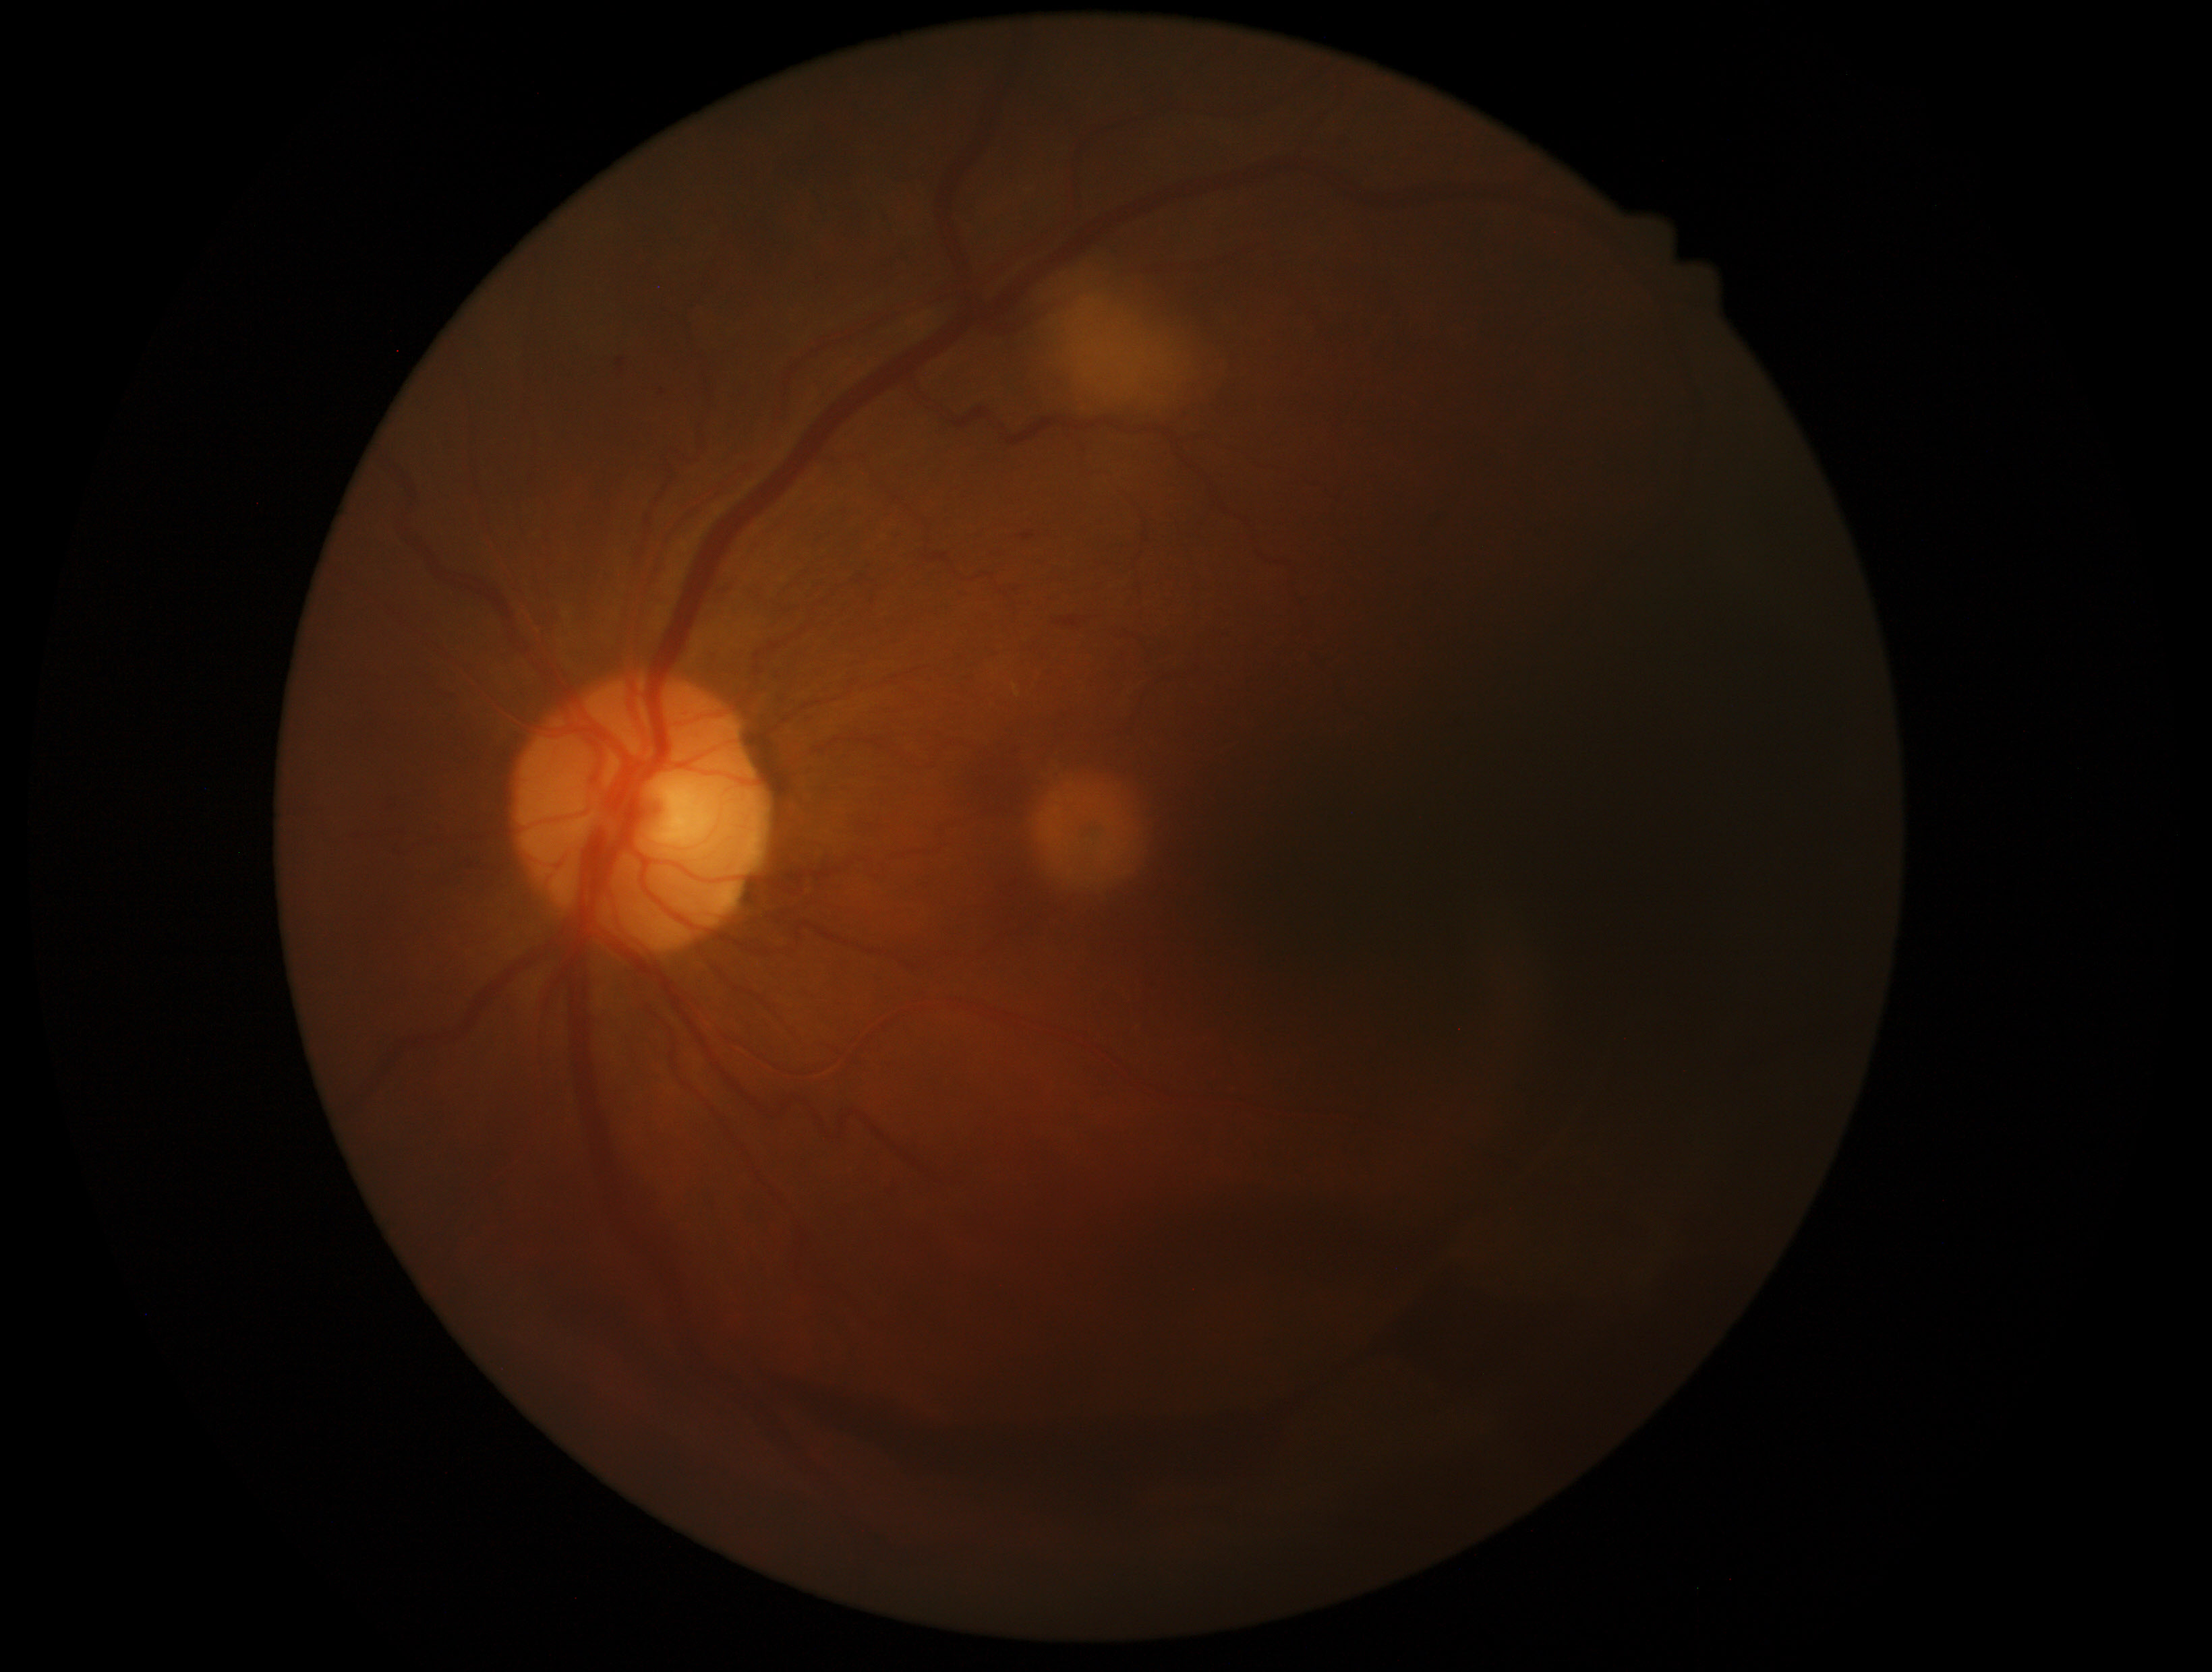

{"dr_grade": "4"}